Captured on a Topcon TRC-50DX fundus camera; 2228 by 1652 pixels — 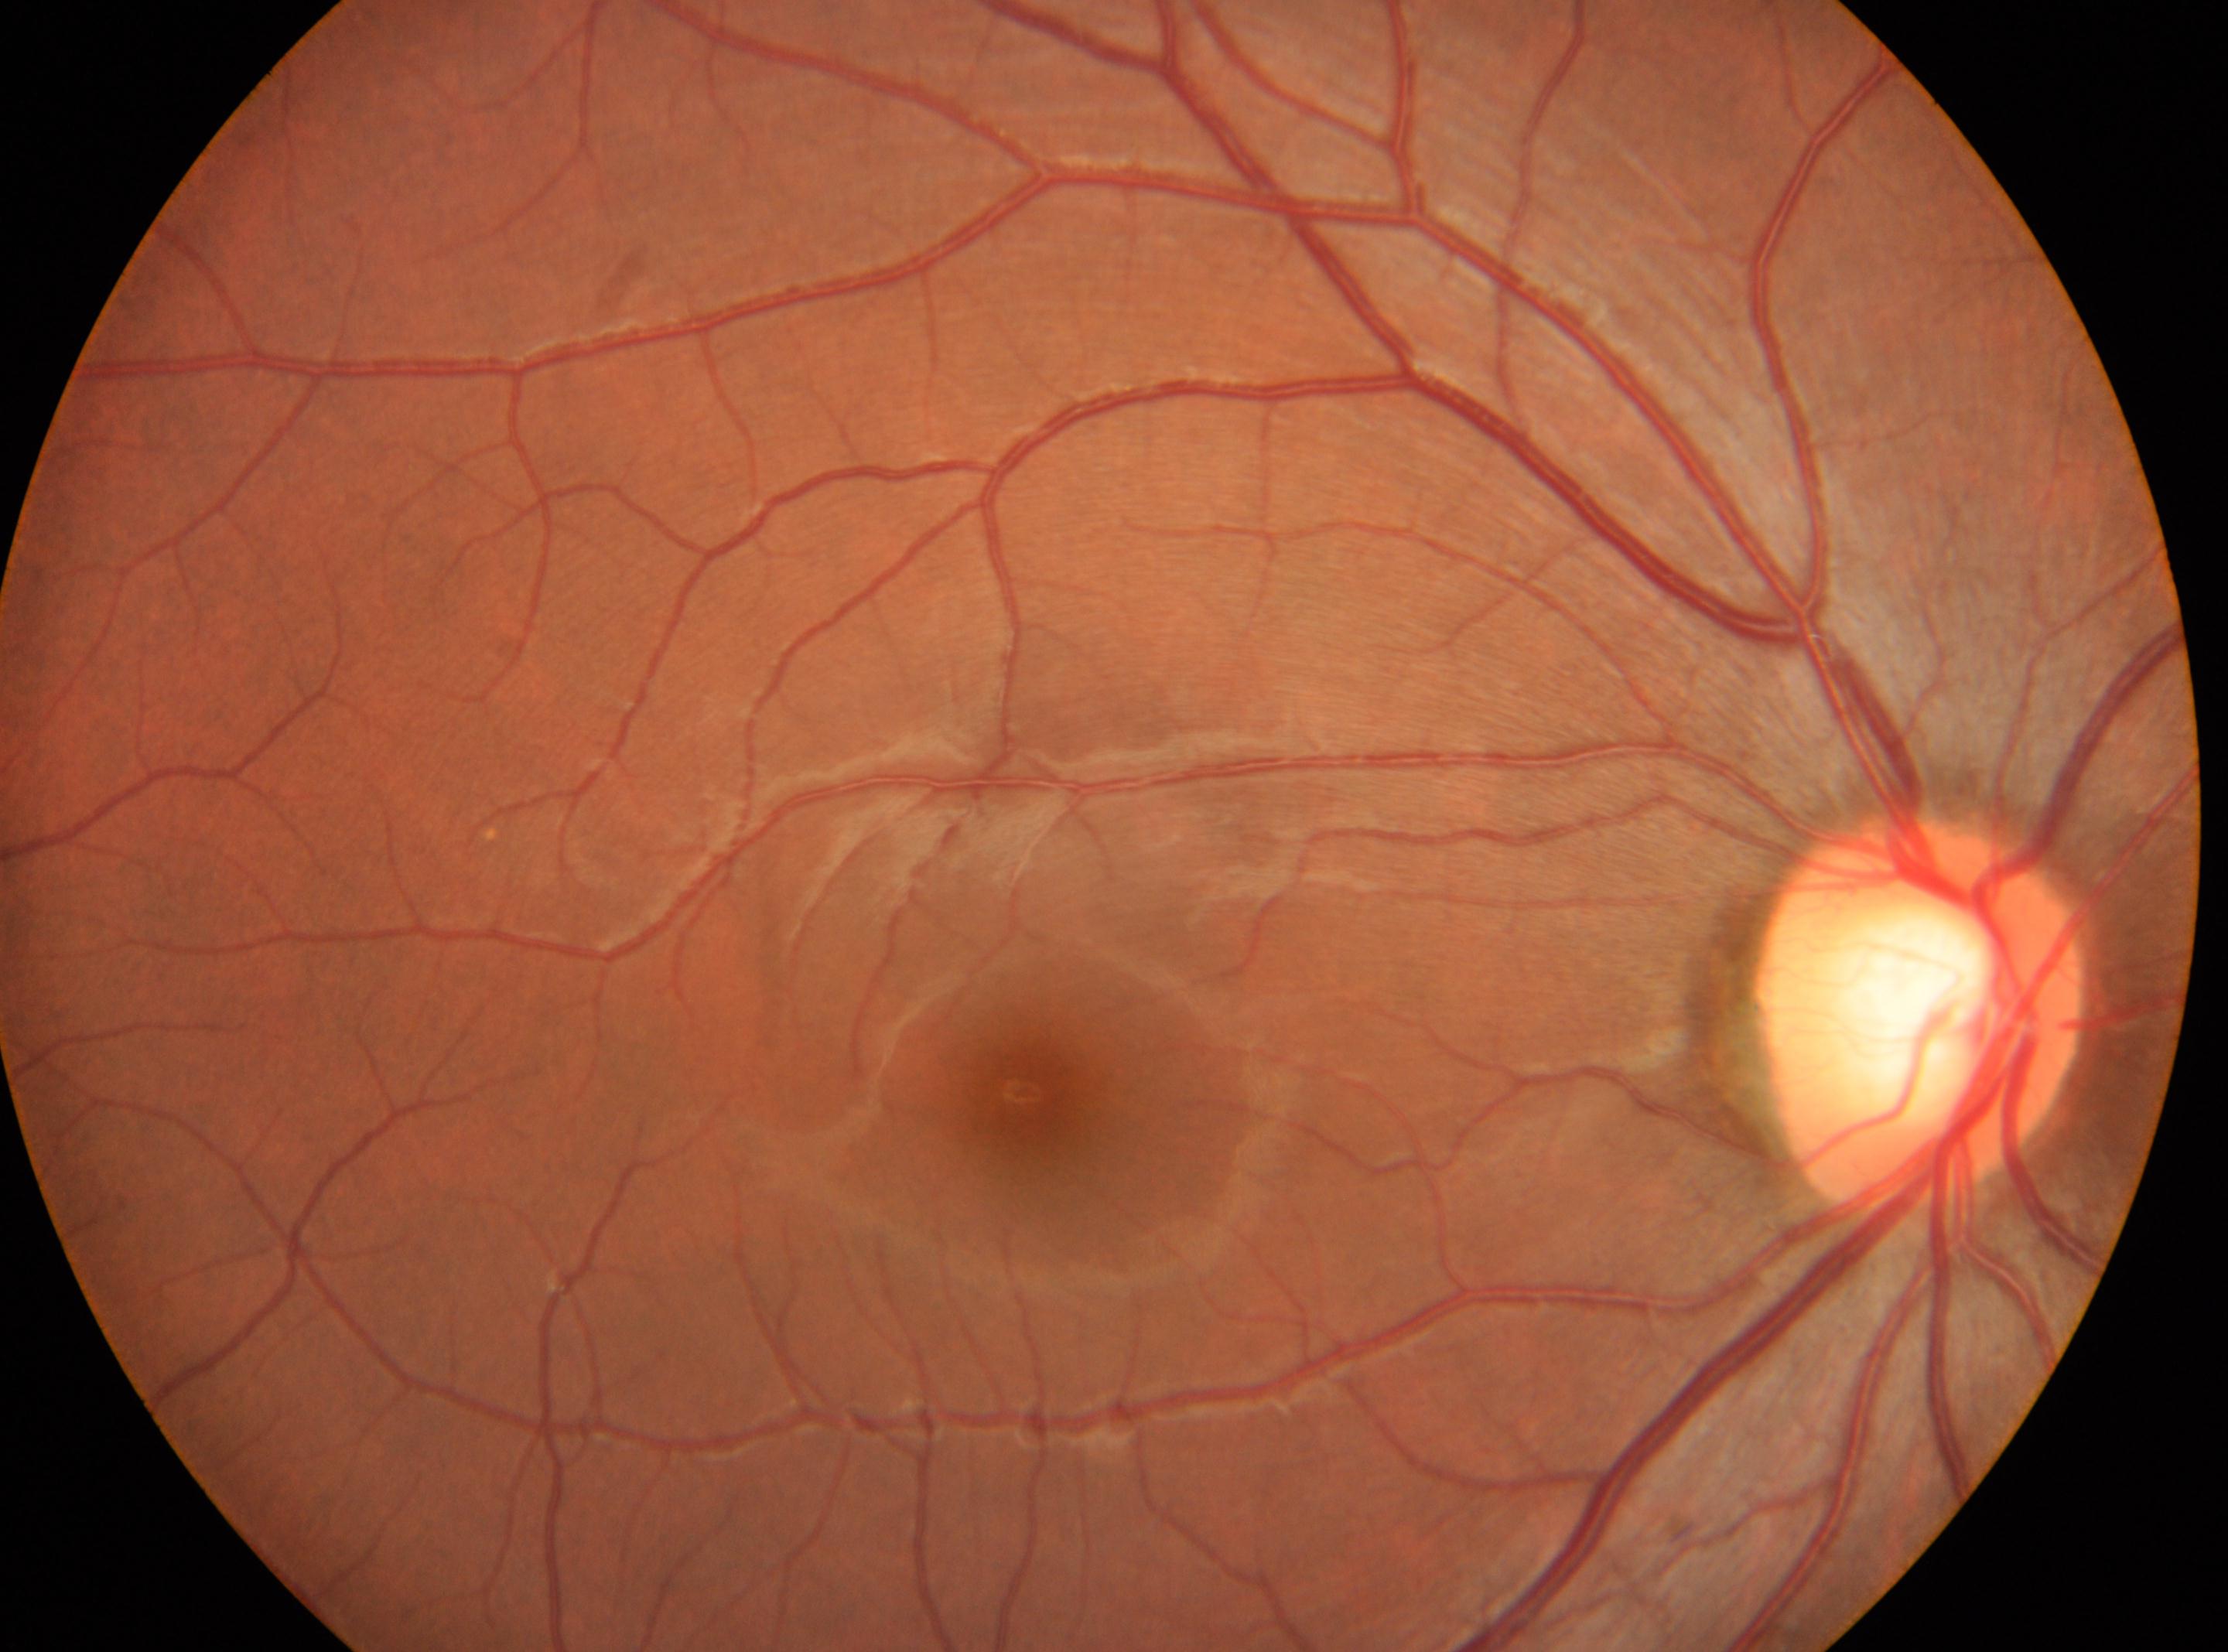 Eye: right. Diabetic retinopathy (DR) is no apparent retinopathy (grade 0). Macular center located at 1023, 1092. Optic disc located at 1921, 1010.